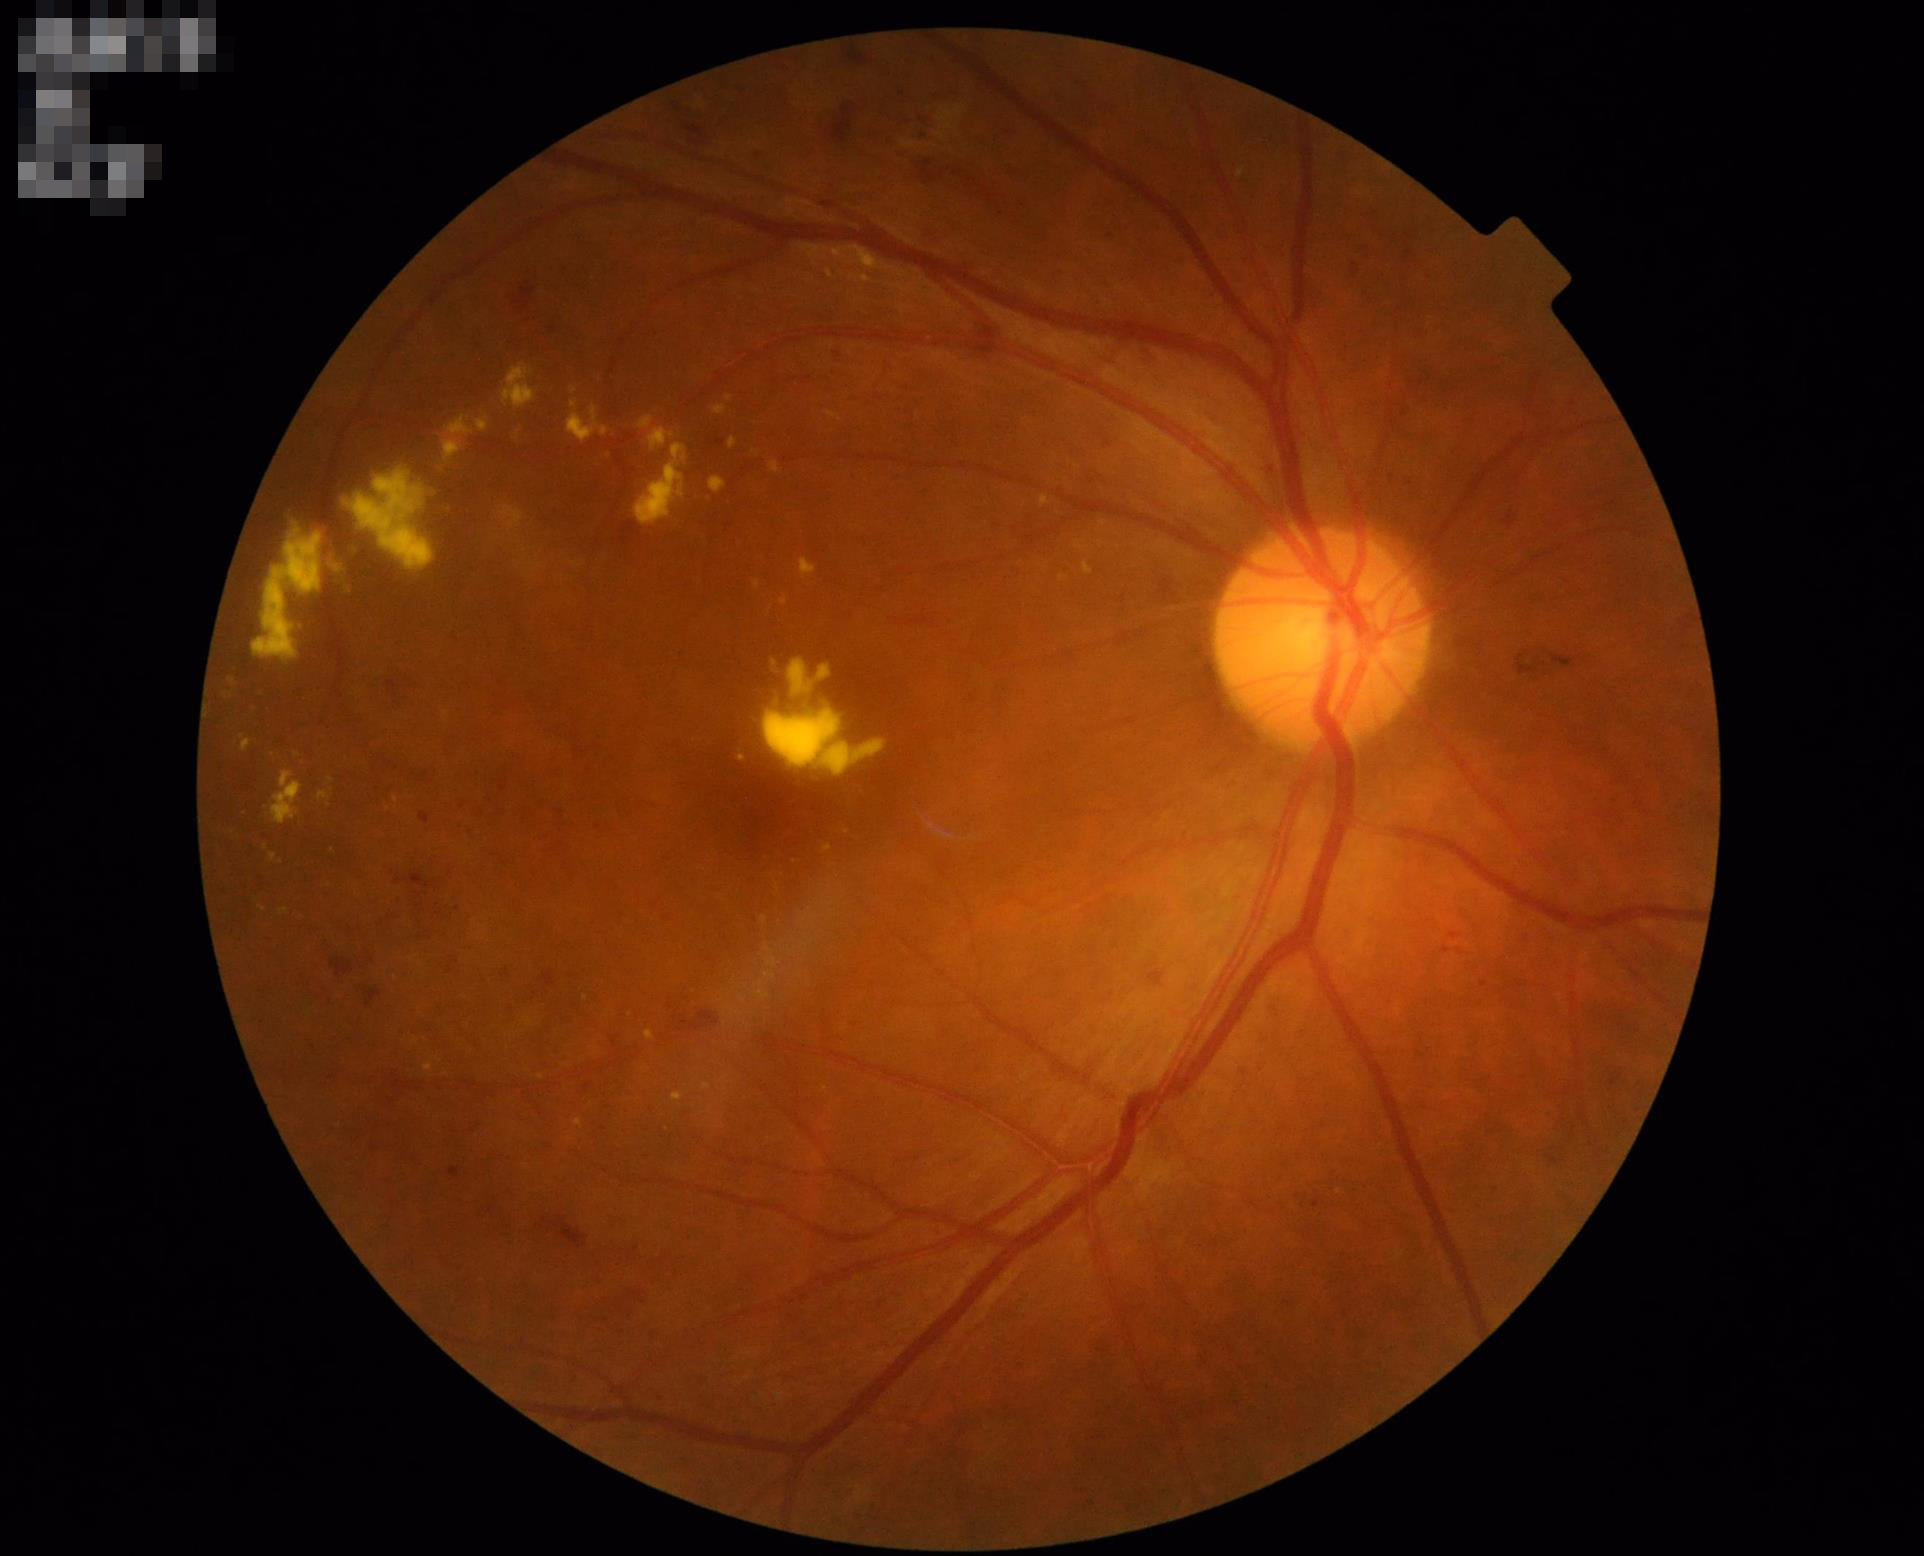

The image is clear. Good dynamic range. Acceptable image quality.